Retinal fundus photograph: 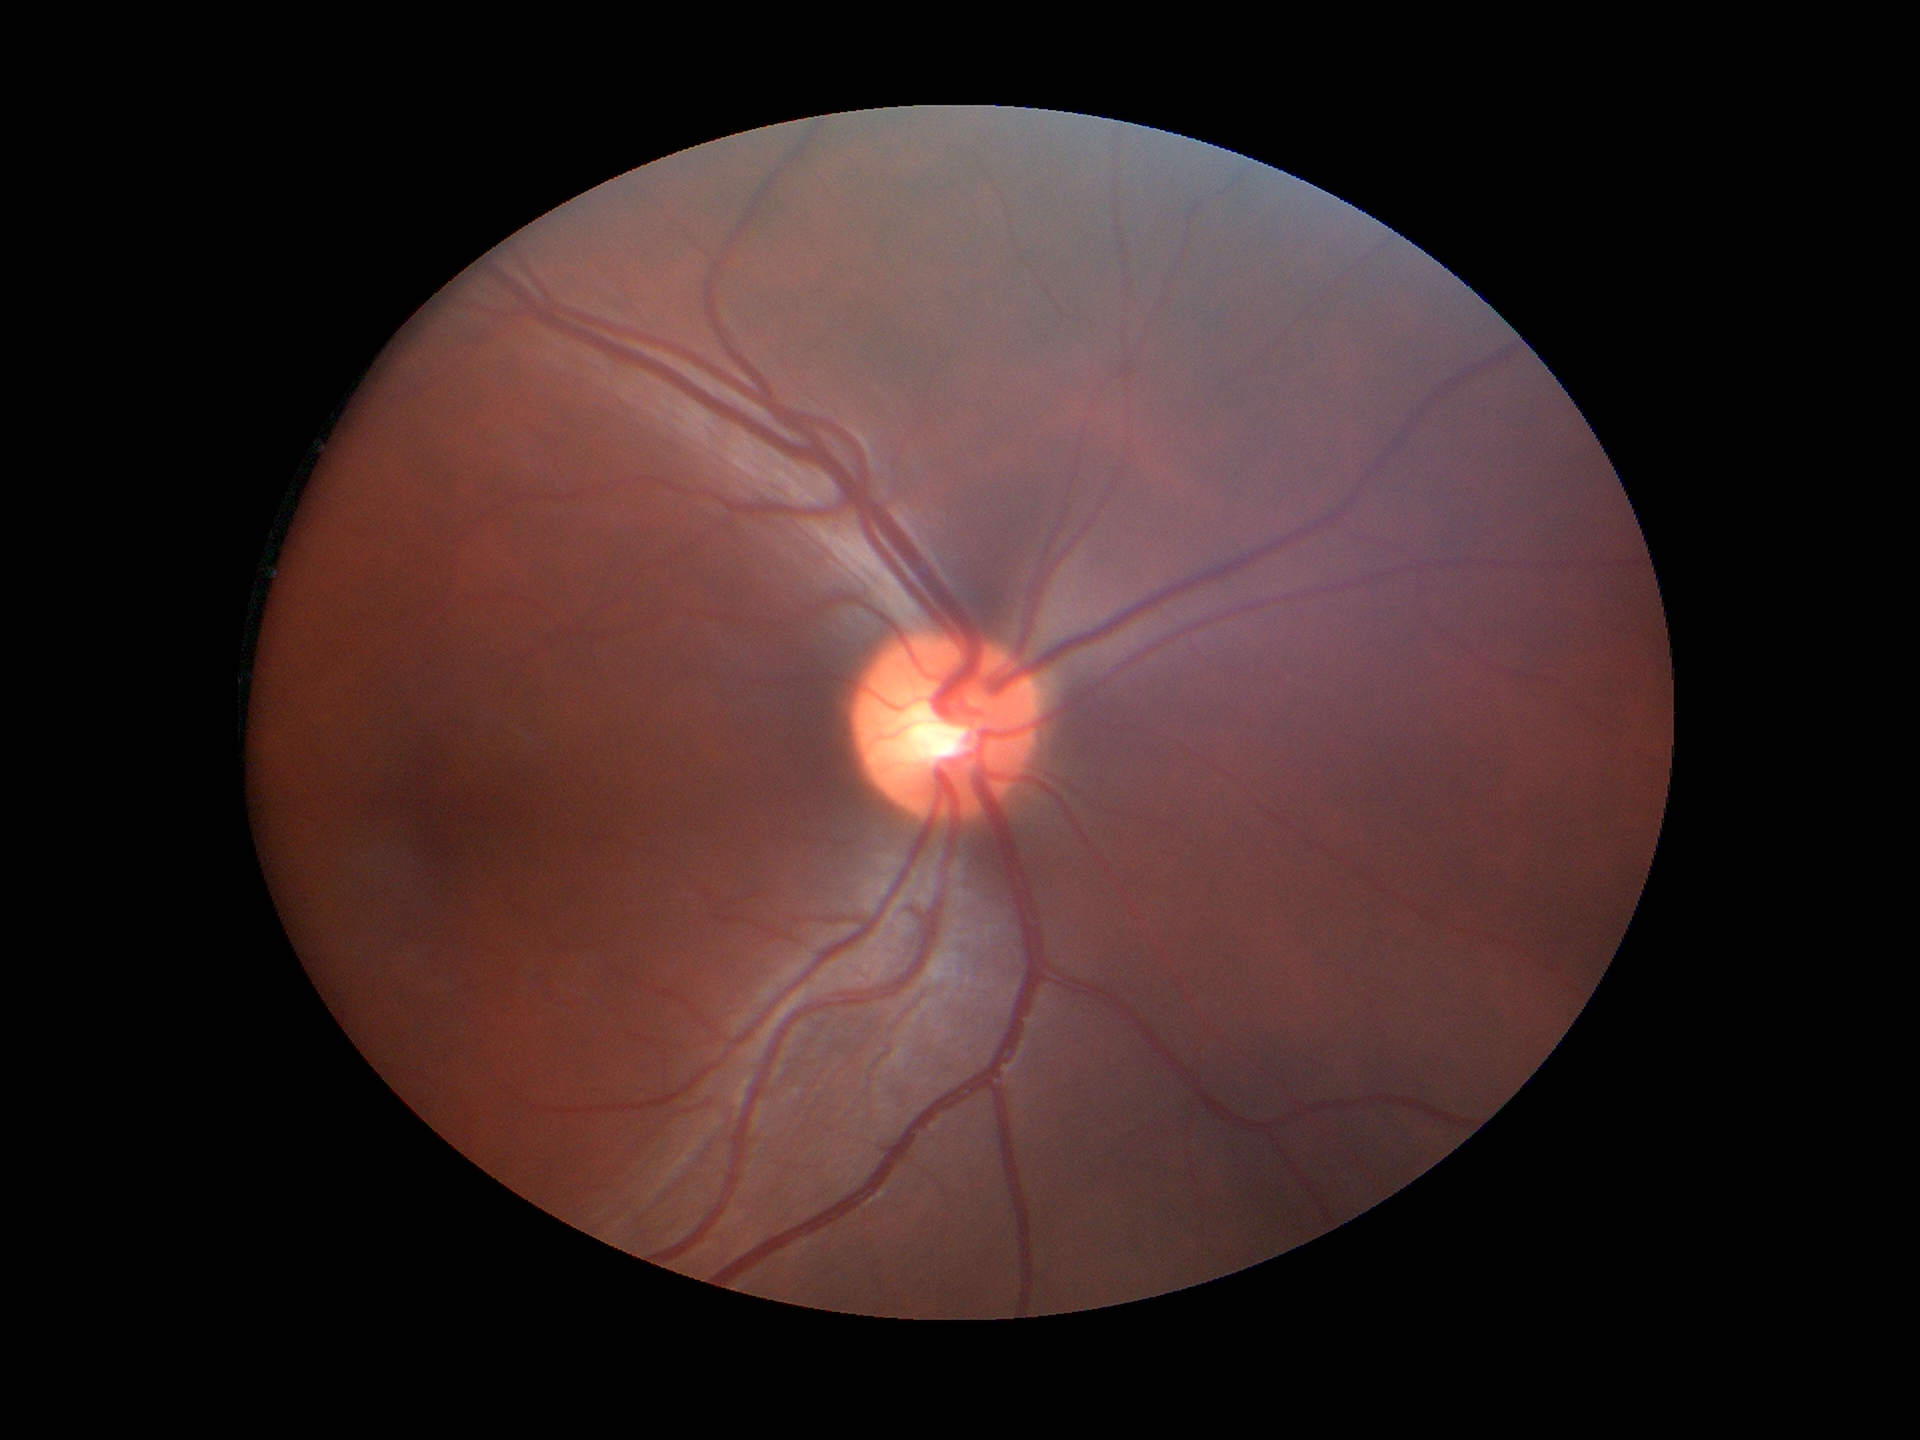

Horizontal CDR (HCDR): 0.49. Glaucoma assessment: not suspect. Vertical cup-to-disc ratio (VCDR) of 0.46.